45° field of view. Fundus photo. 2212x1659px:
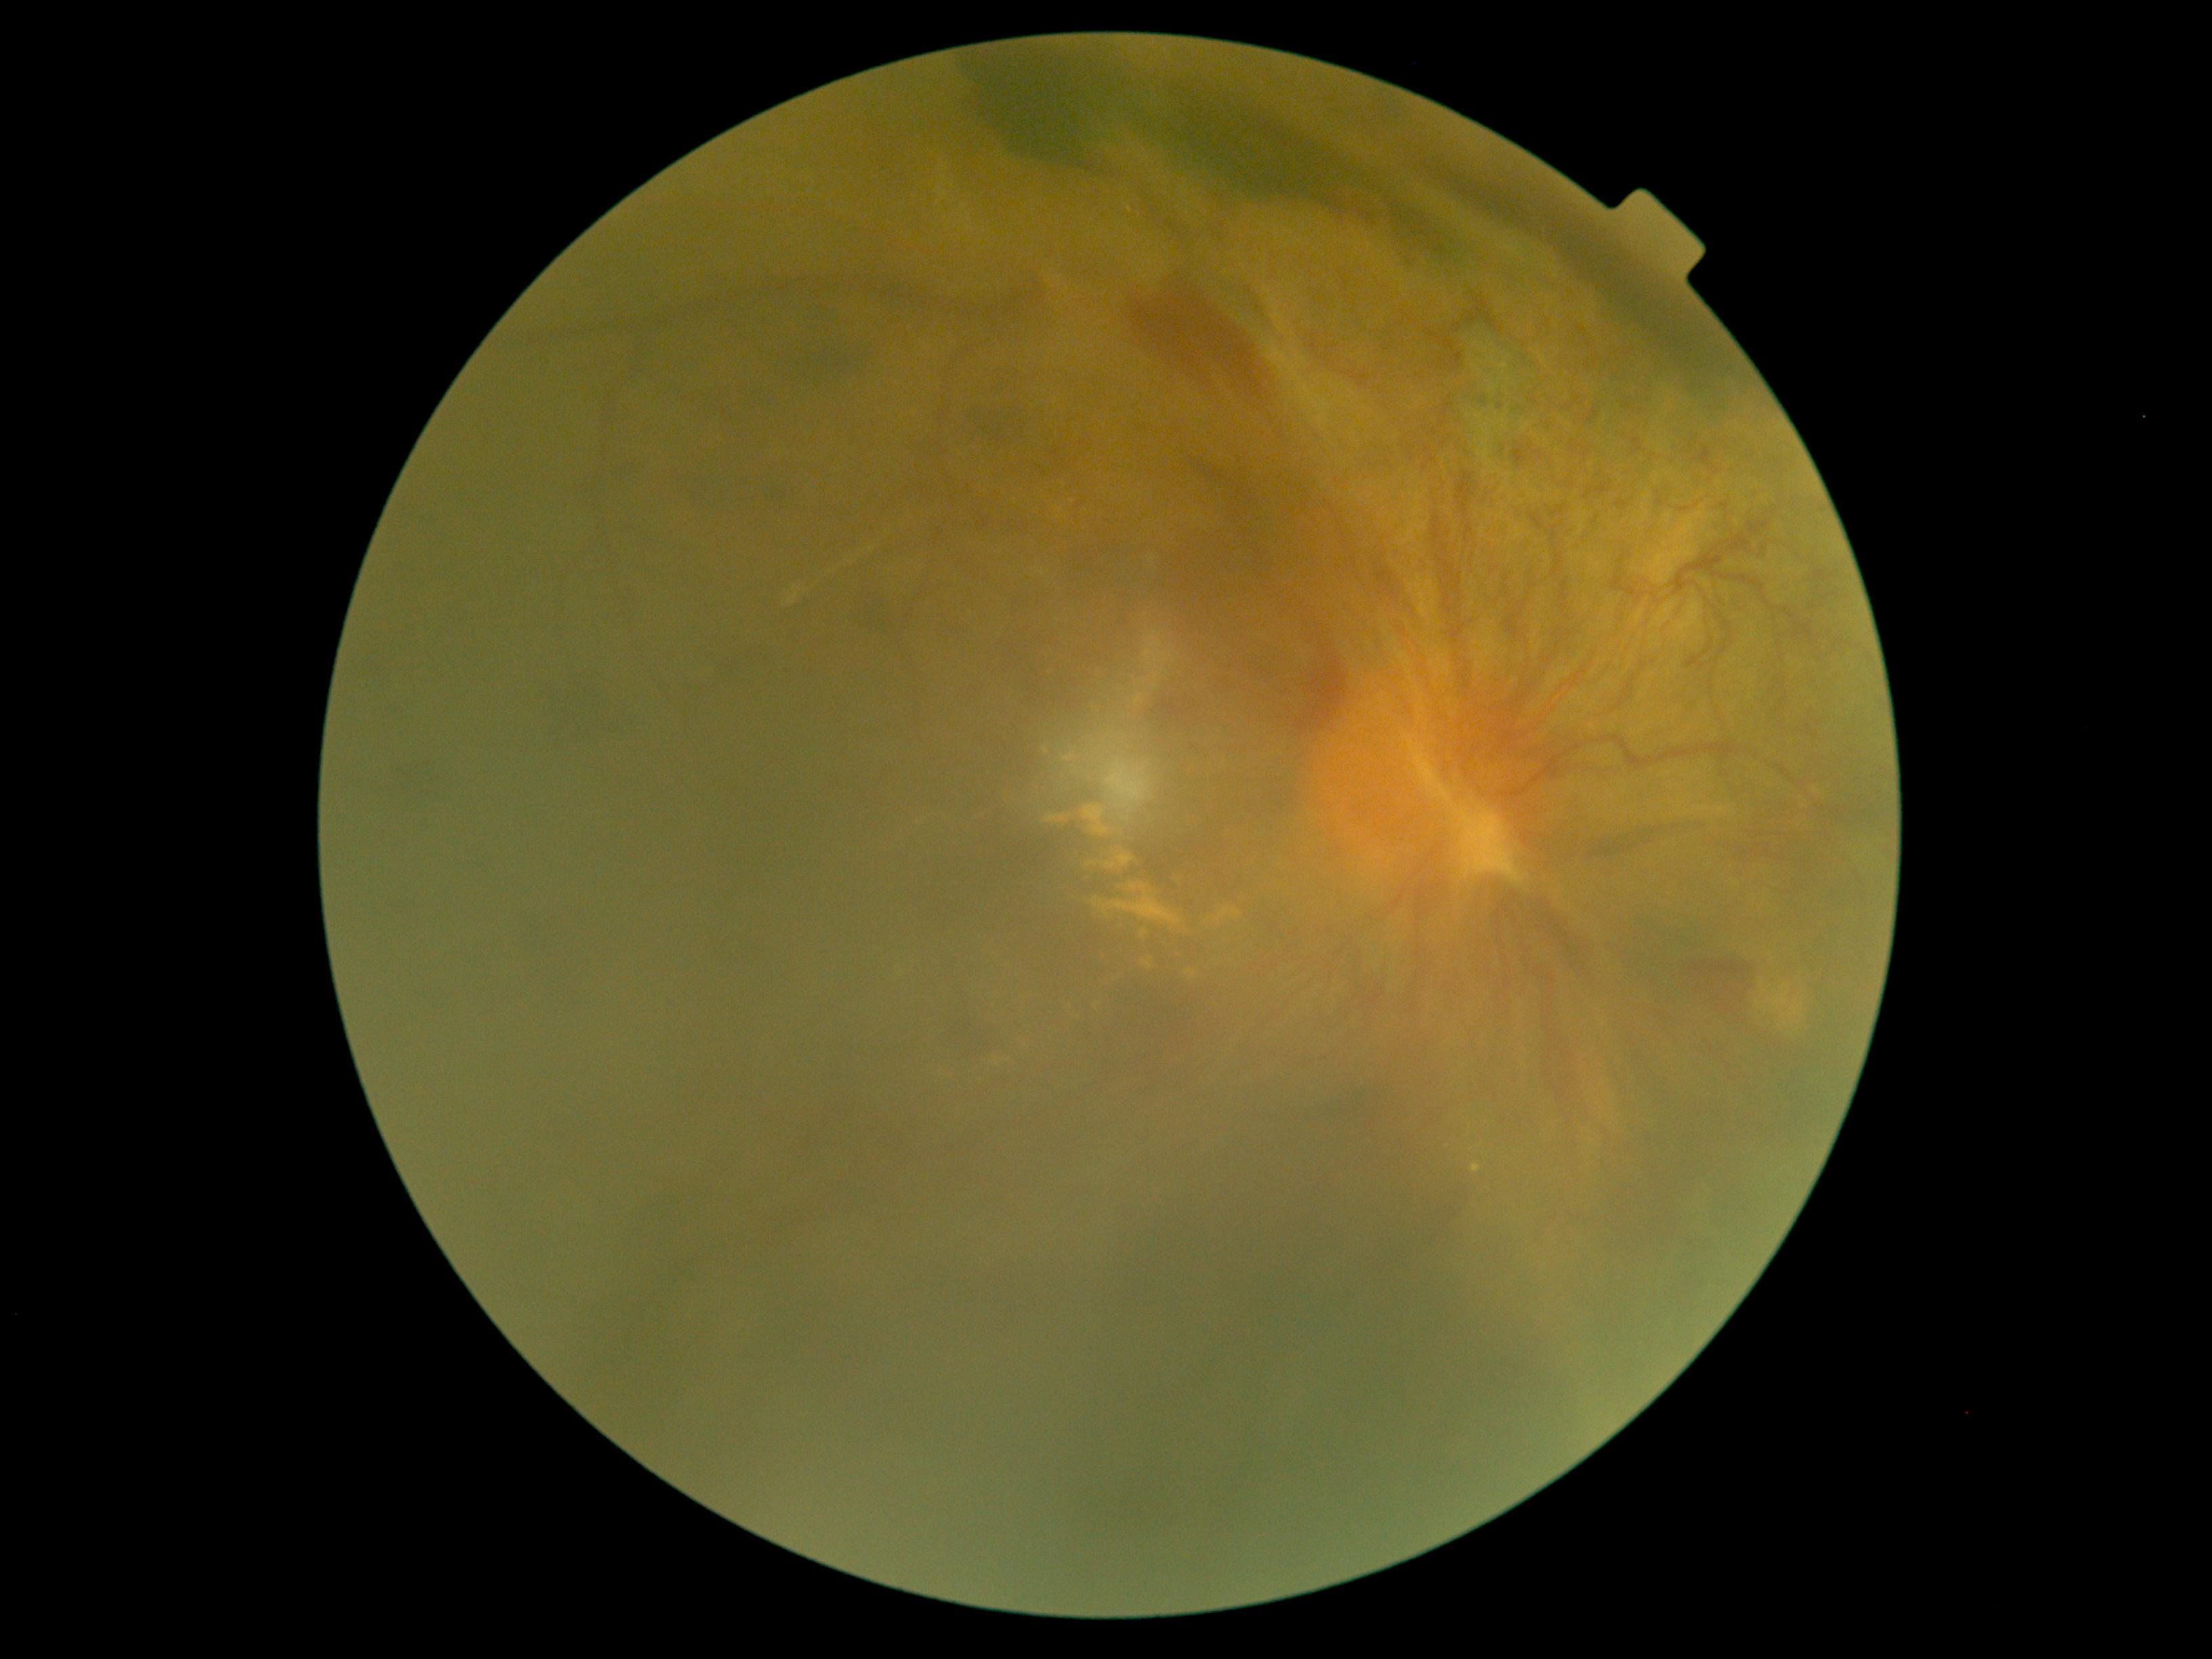

Diabetic retinopathy (DR): grade 4 (PDR). The retinopathy is classified as proliferative diabetic retinopathy.